Graded on the modified Davis scale; CFP.
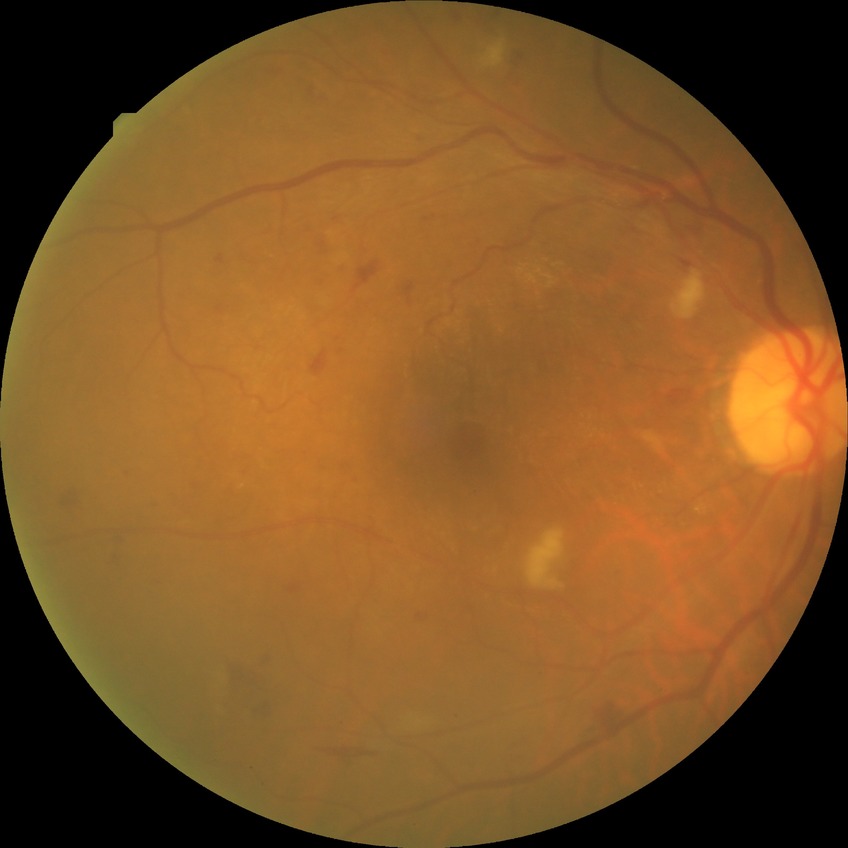

DR severity=PPDR.